NIDEK AFC-230 fundus camera, FOV: 45 degrees: 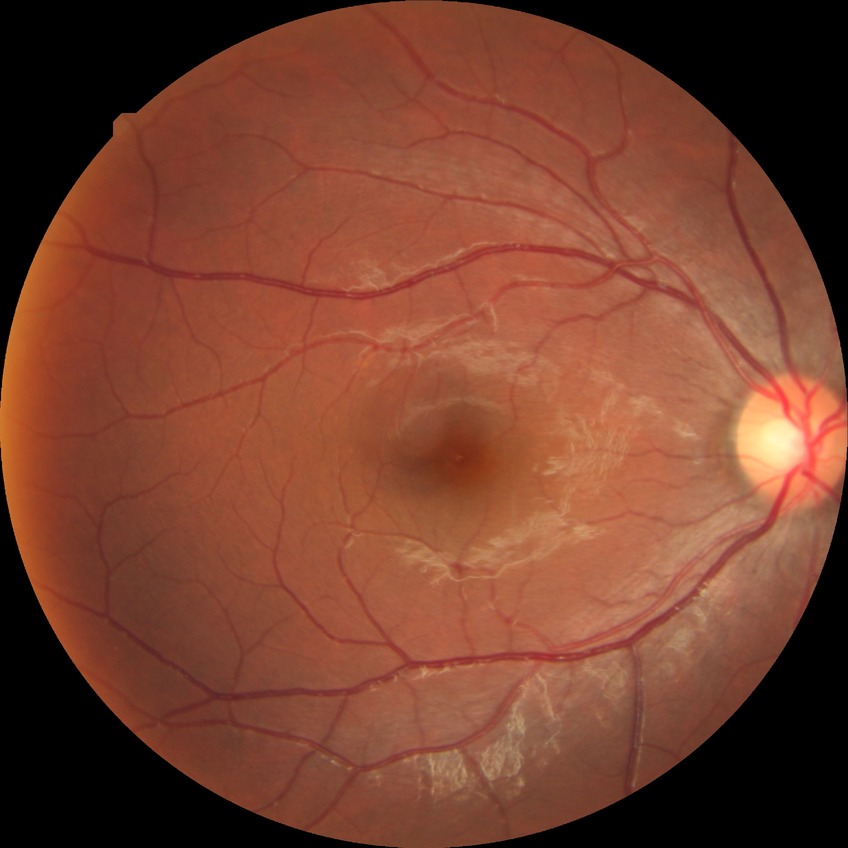 Modified Davis classification: no diabetic retinopathy.